Camera: Topcon TRC-50DX · dilated-pupil acquisition: 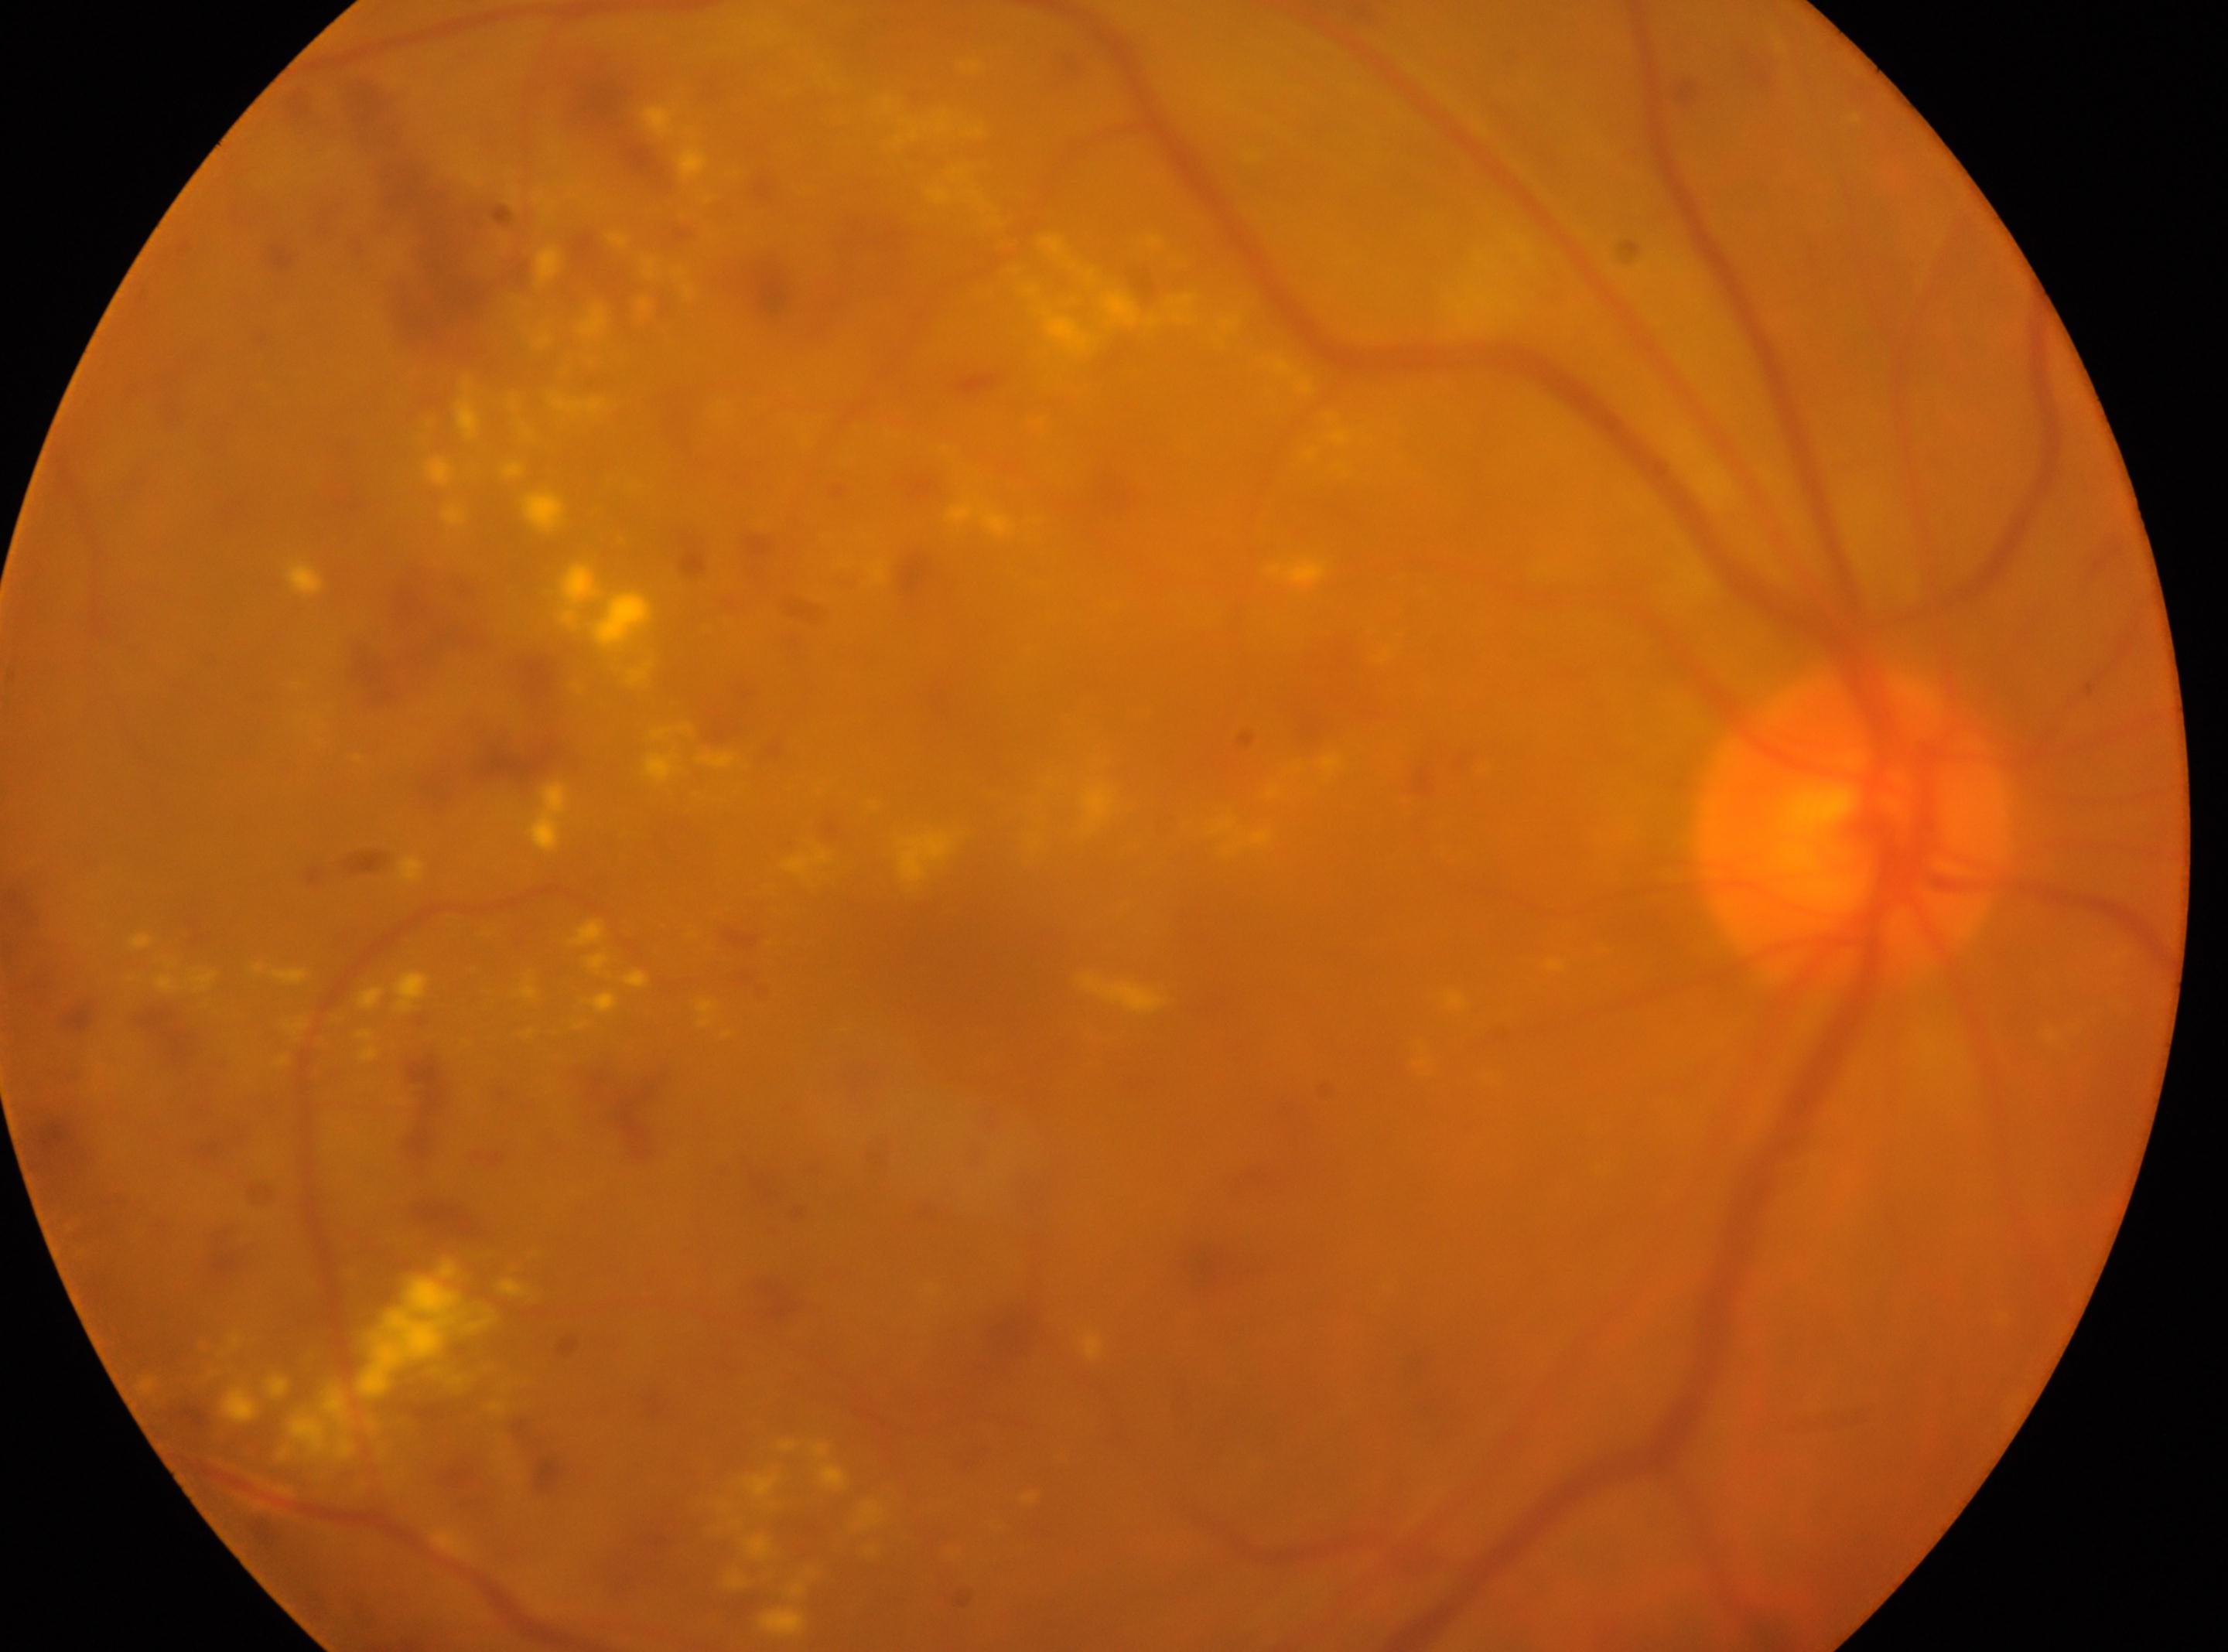
diabetic retinopathy: 3 — more than 20 intraretinal hemorrhages in each of 4 quadrants, definite venous beading in 2 or more quadrants, or prominent intraretinal microvascular abnormalities in 1 or more quadrants, with no signs of proliferative retinopathy | the right eye | foveal center: (948,940) | disc center: (1850,826).